Color fundus photograph, 45° FOV — 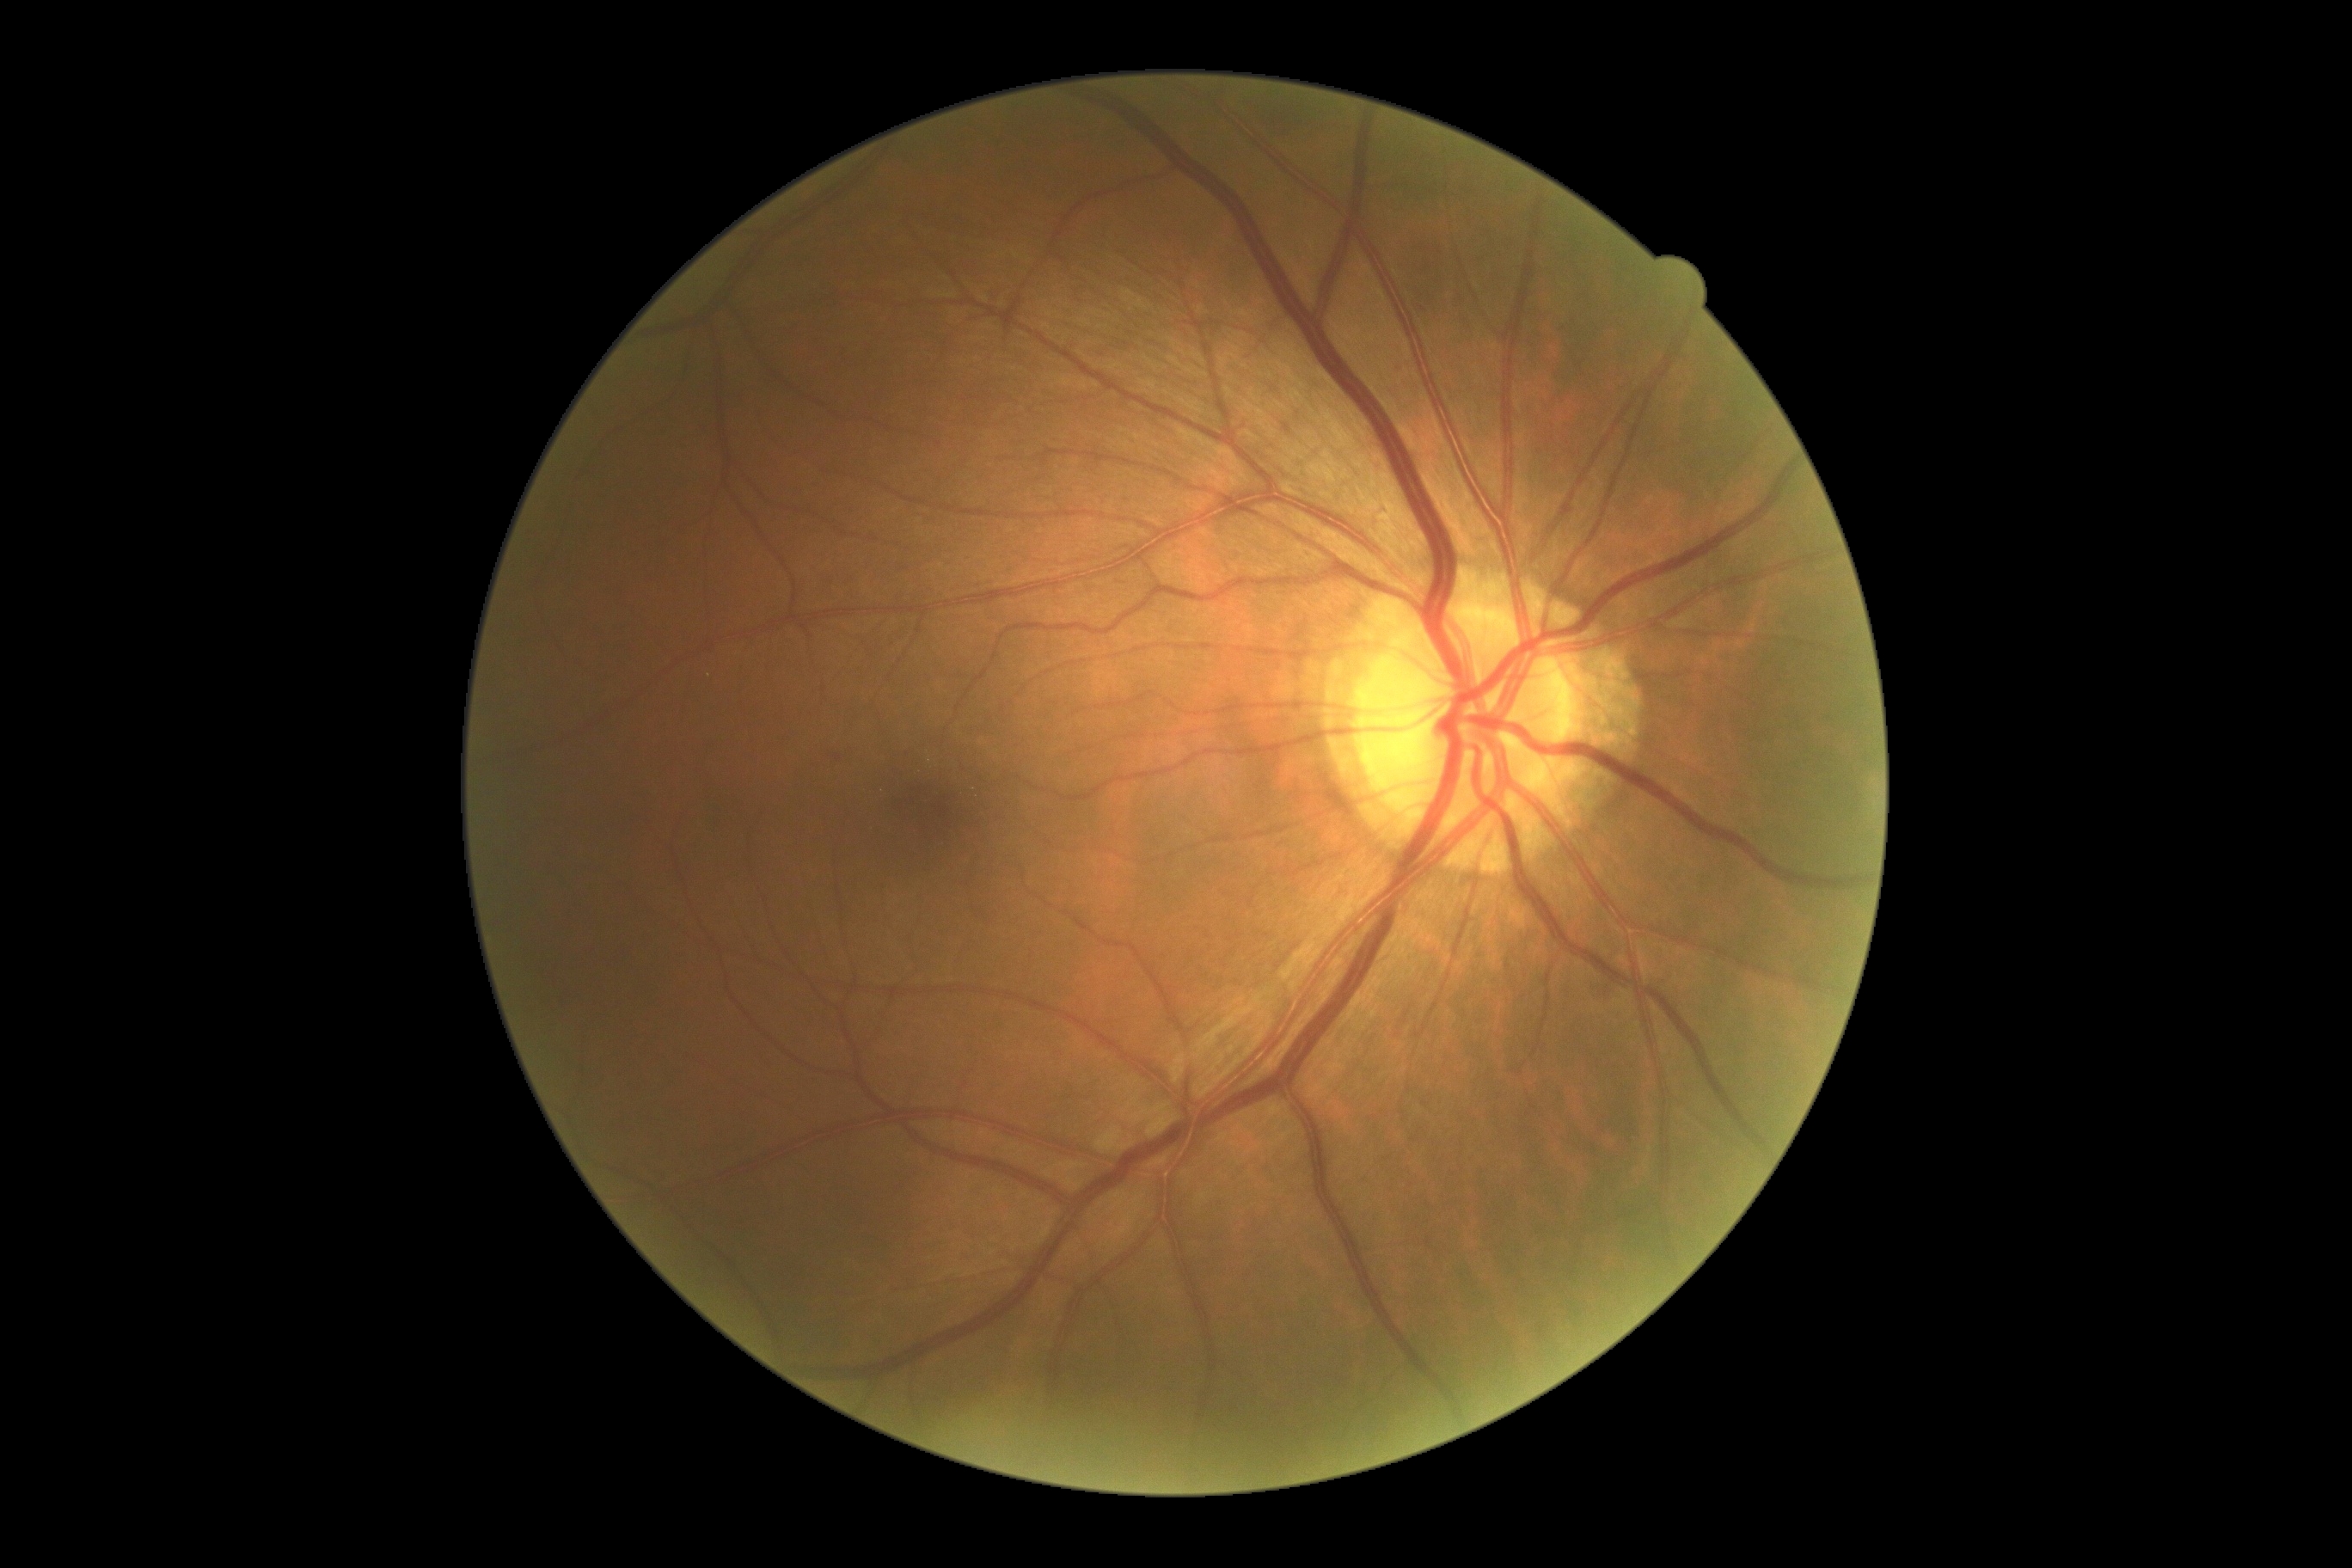
DR stage=no apparent retinopathy (grade 0).